848 x 848 pixels, NIDEK AFC-230 fundus camera, fundus photo, no pharmacologic dilation
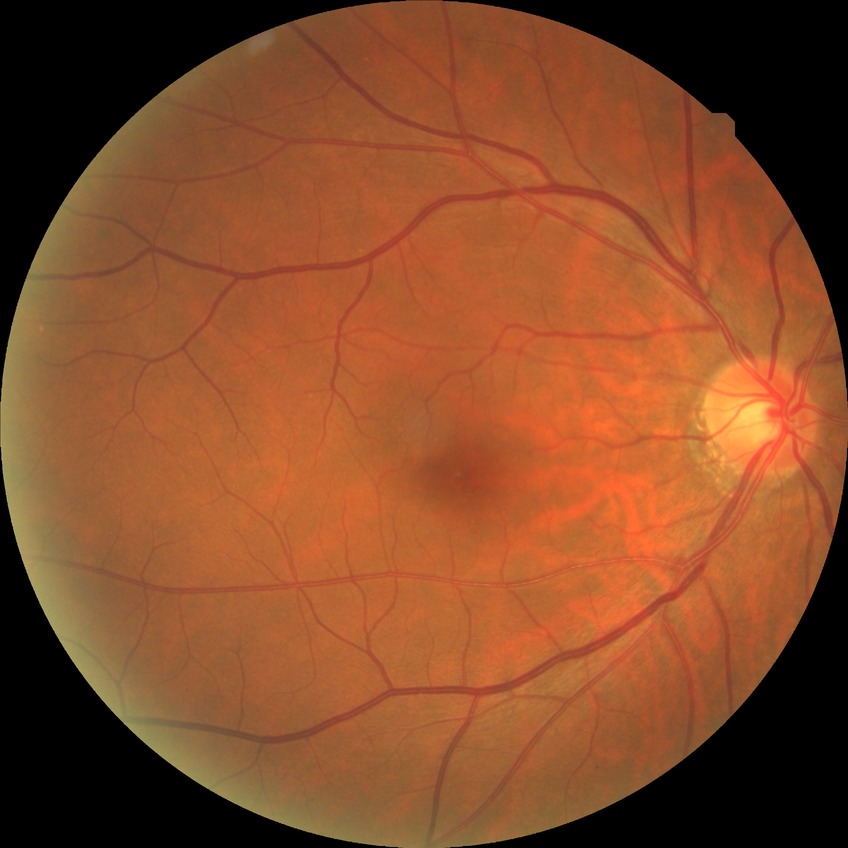
Annotations:
- diabetic retinopathy (DR): NDR (no diabetic retinopathy)